Posterior pole photograph; camera: NIDEK AFC-230 — 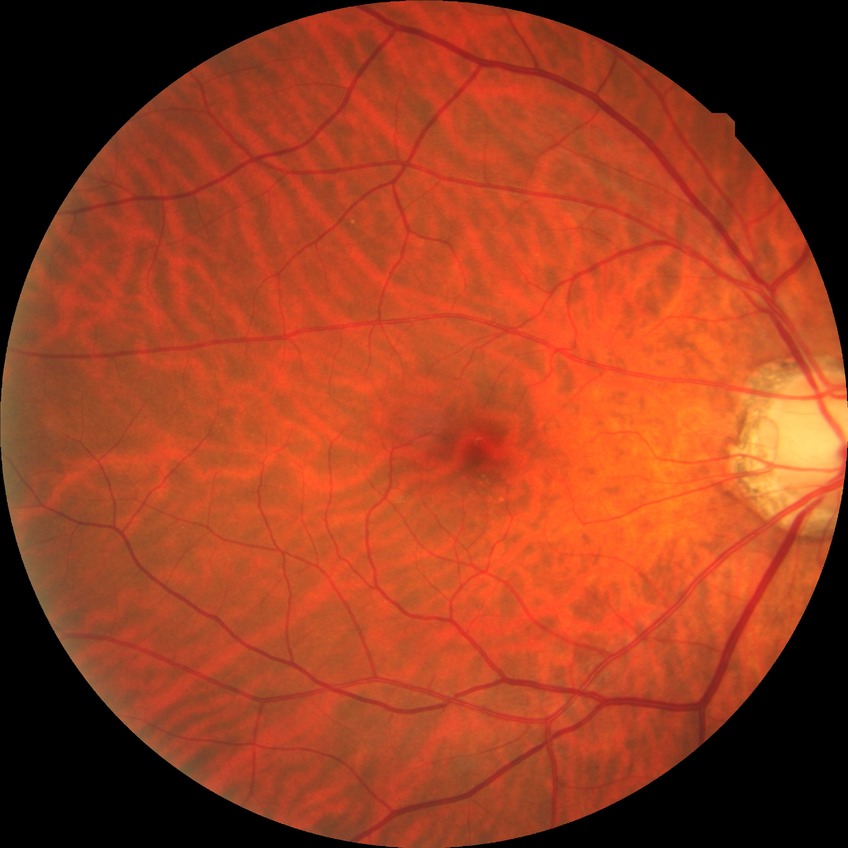

Diabetic retinopathy severity: no diabetic retinopathy.